240 by 240 pixels.
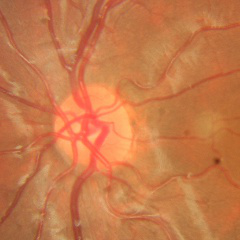
No glaucoma.